CFP.
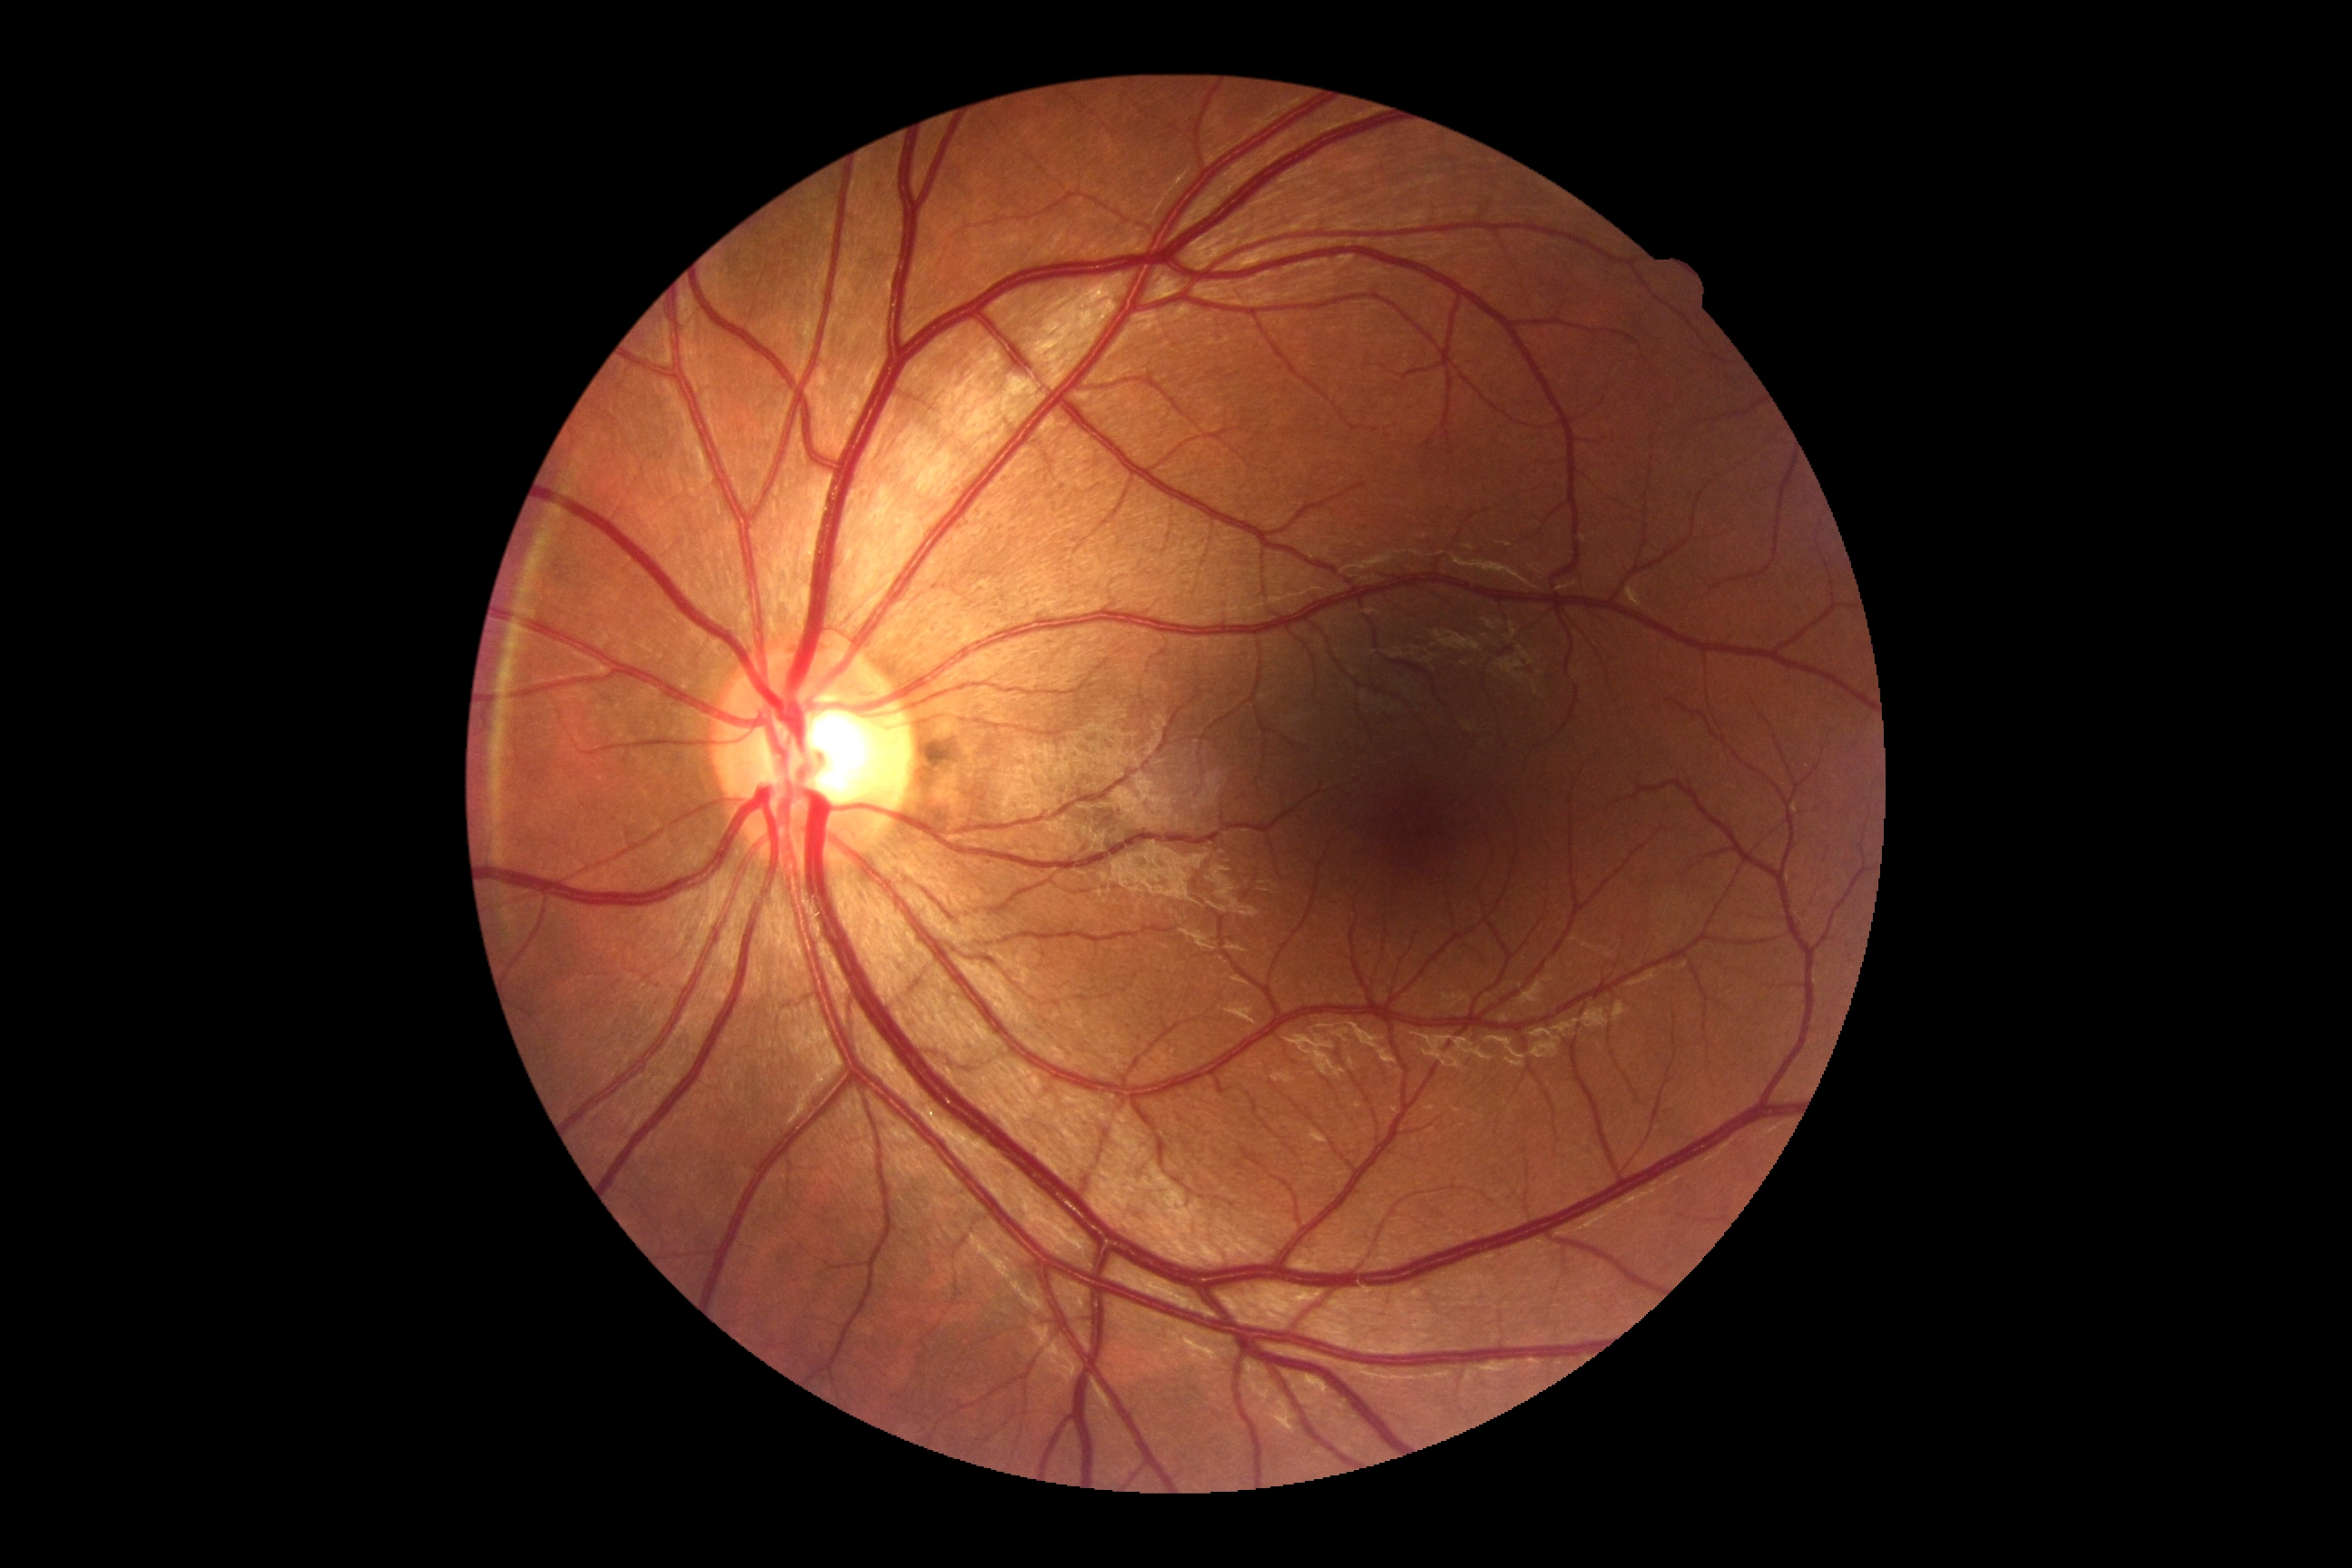 Retinopathy: grade 0 (no apparent retinopathy) — no visible signs of diabetic retinopathy.